Color fundus image; FOV: 45 degrees; image size 2352x1568.
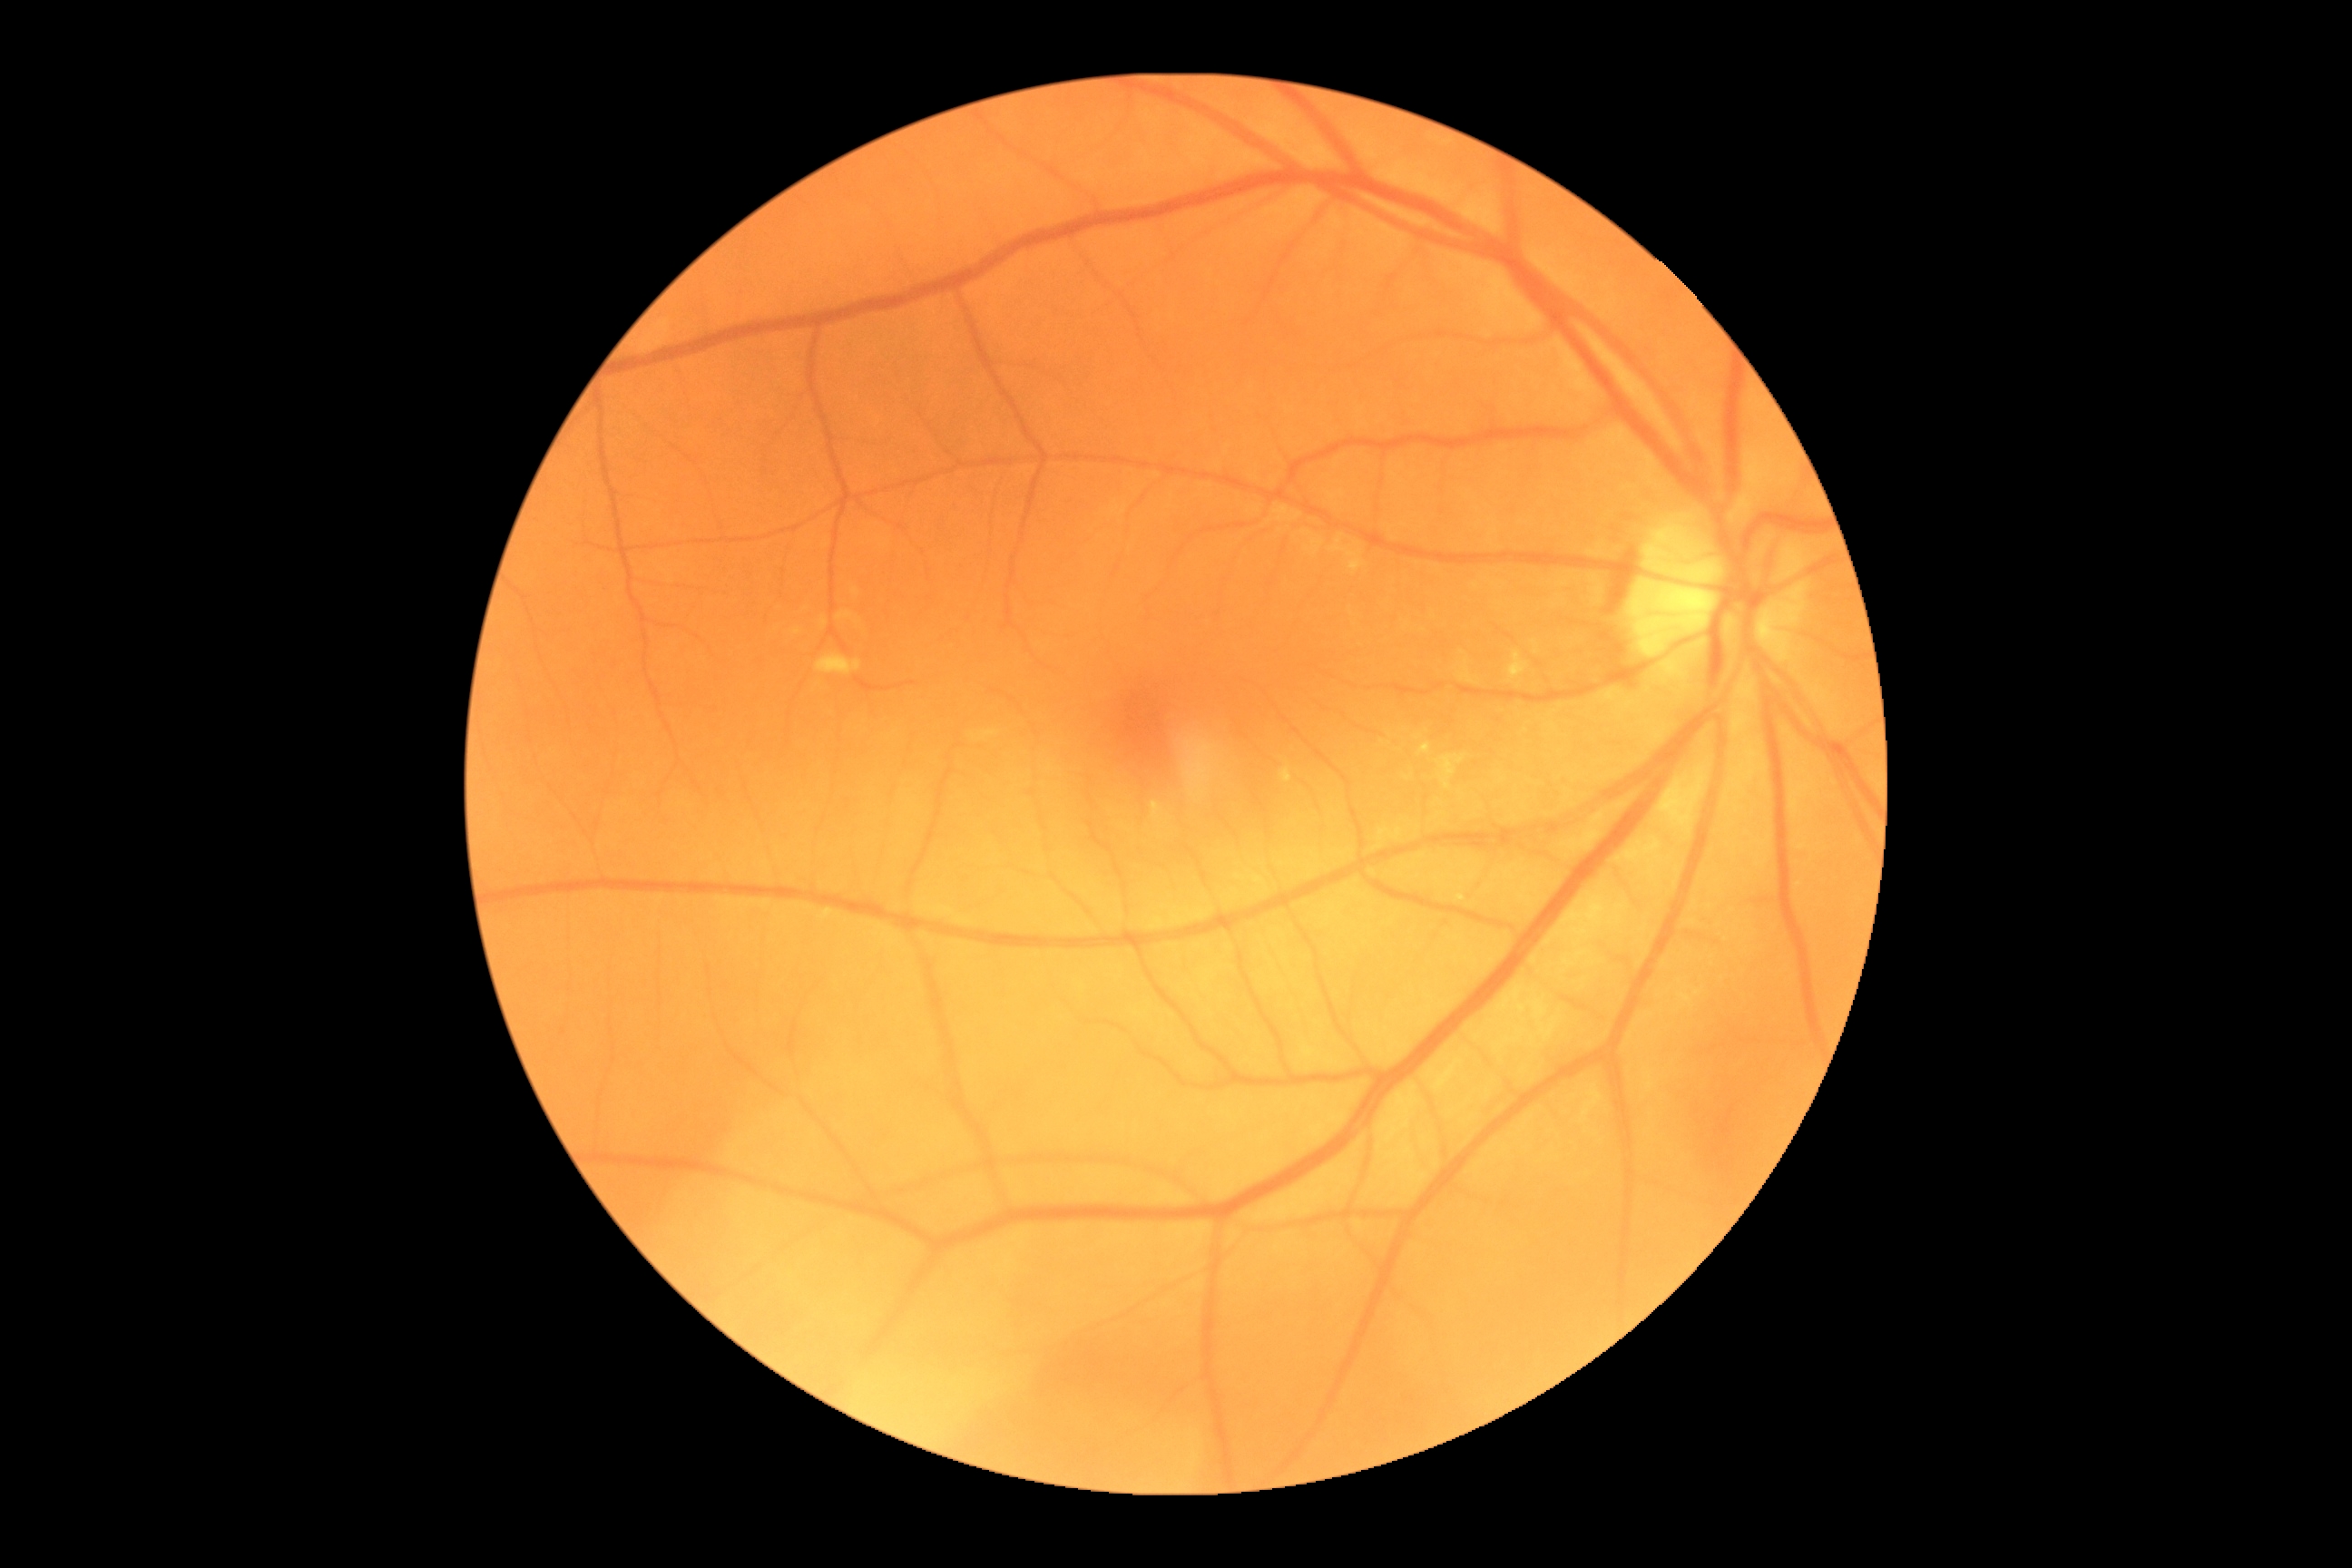
Retinopathy grade is 0.